Color fundus photograph
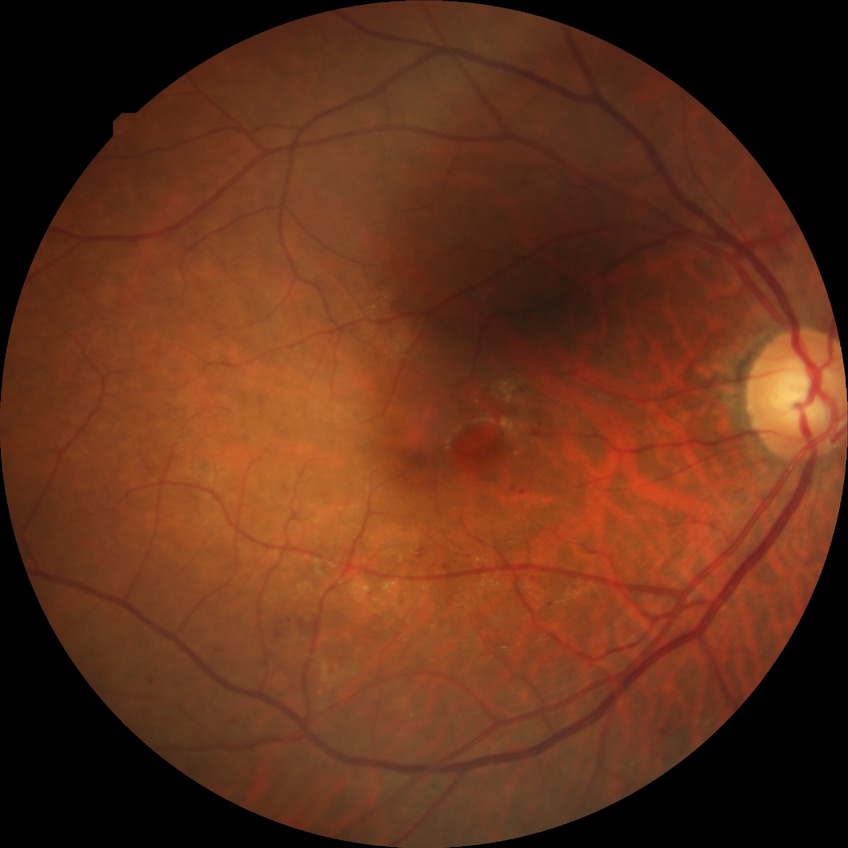
retinopathy grade = simple diabetic retinopathy.